45° field of view, 1380 x 1382 pixels
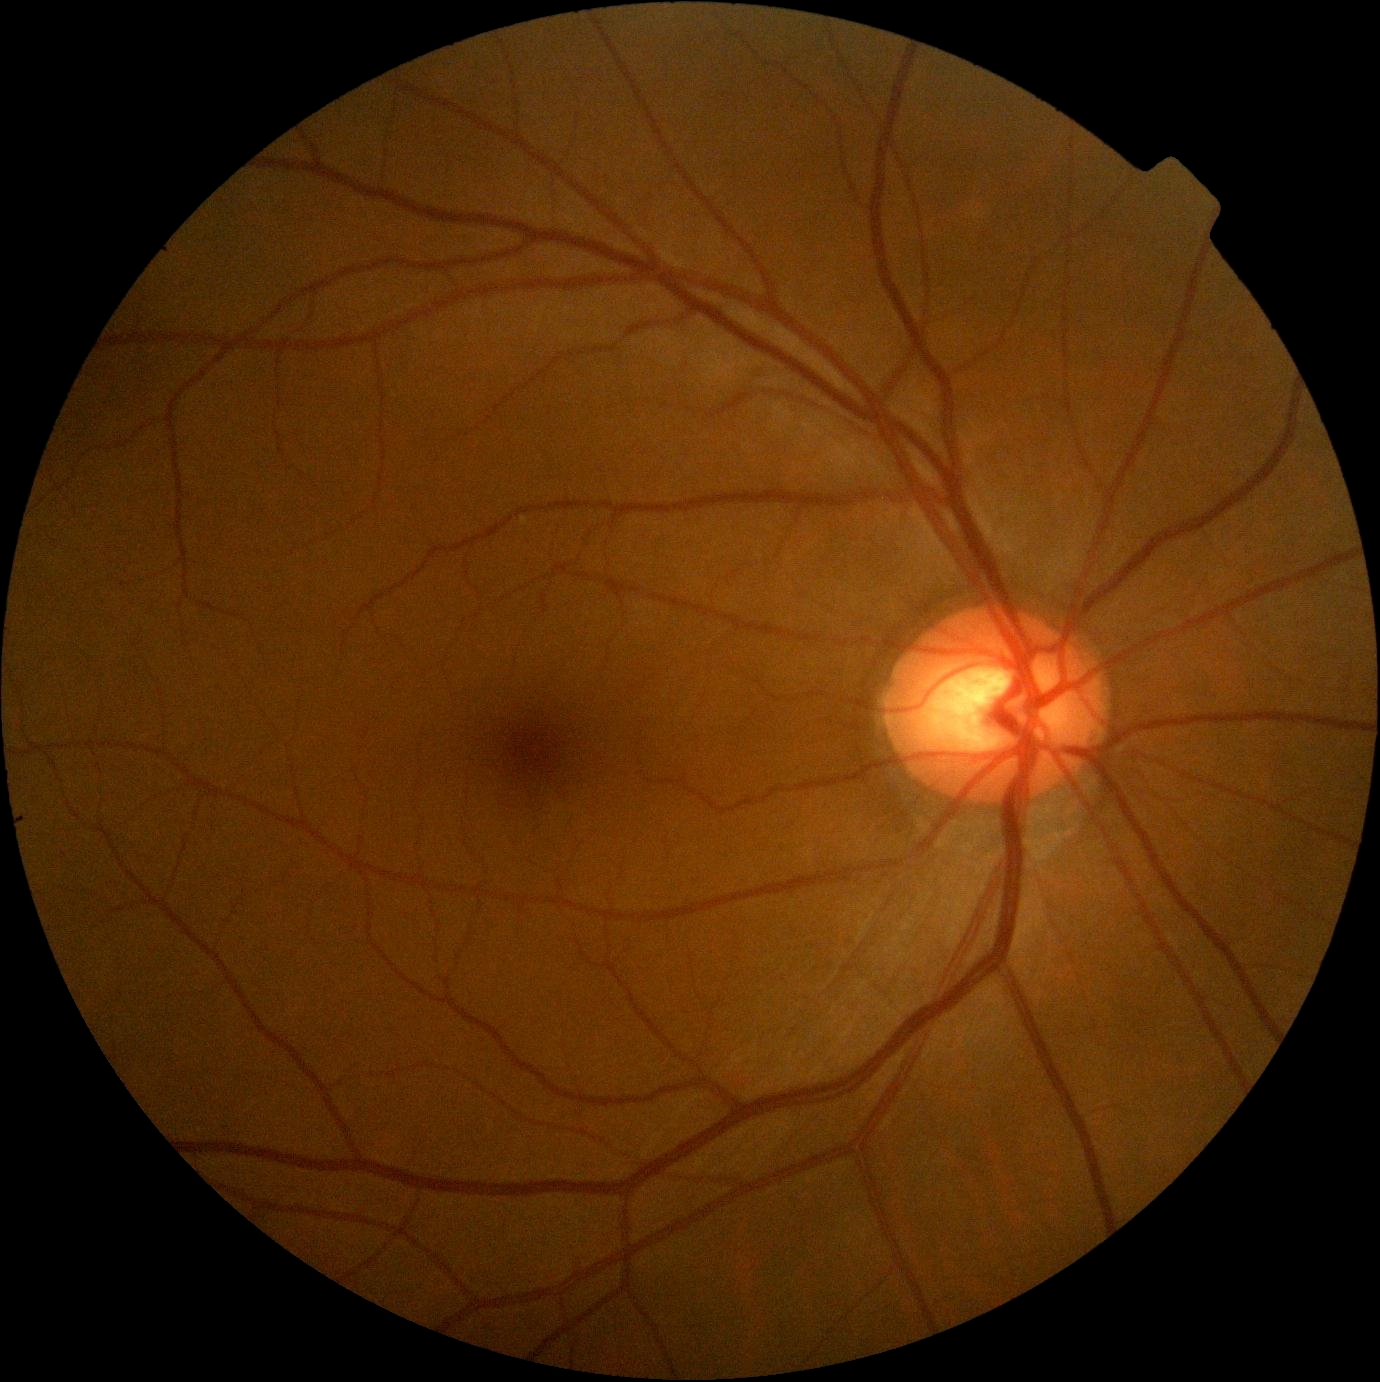

Diabetic retinopathy severity is 0 — no visible signs of diabetic retinopathy.